Acquired with a Nidek AFC-330
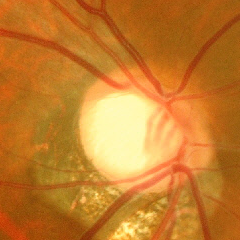 Glaucoma stage: advanced glaucomatous optic neuropathy.